Wide-field fundus photograph of an infant · Clarity RetCam 3, 130° FOV.
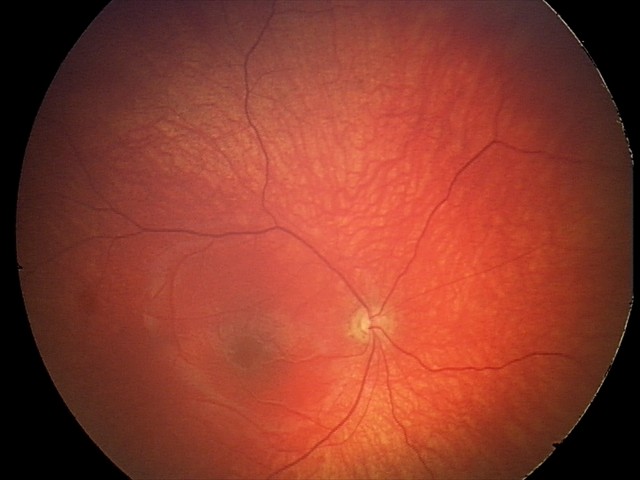 Q: What is the diagnosis from this examination?
A: optic nerve hypoplasia